Acquired with a Remidio FOP fundus camera, retinal fundus photograph:
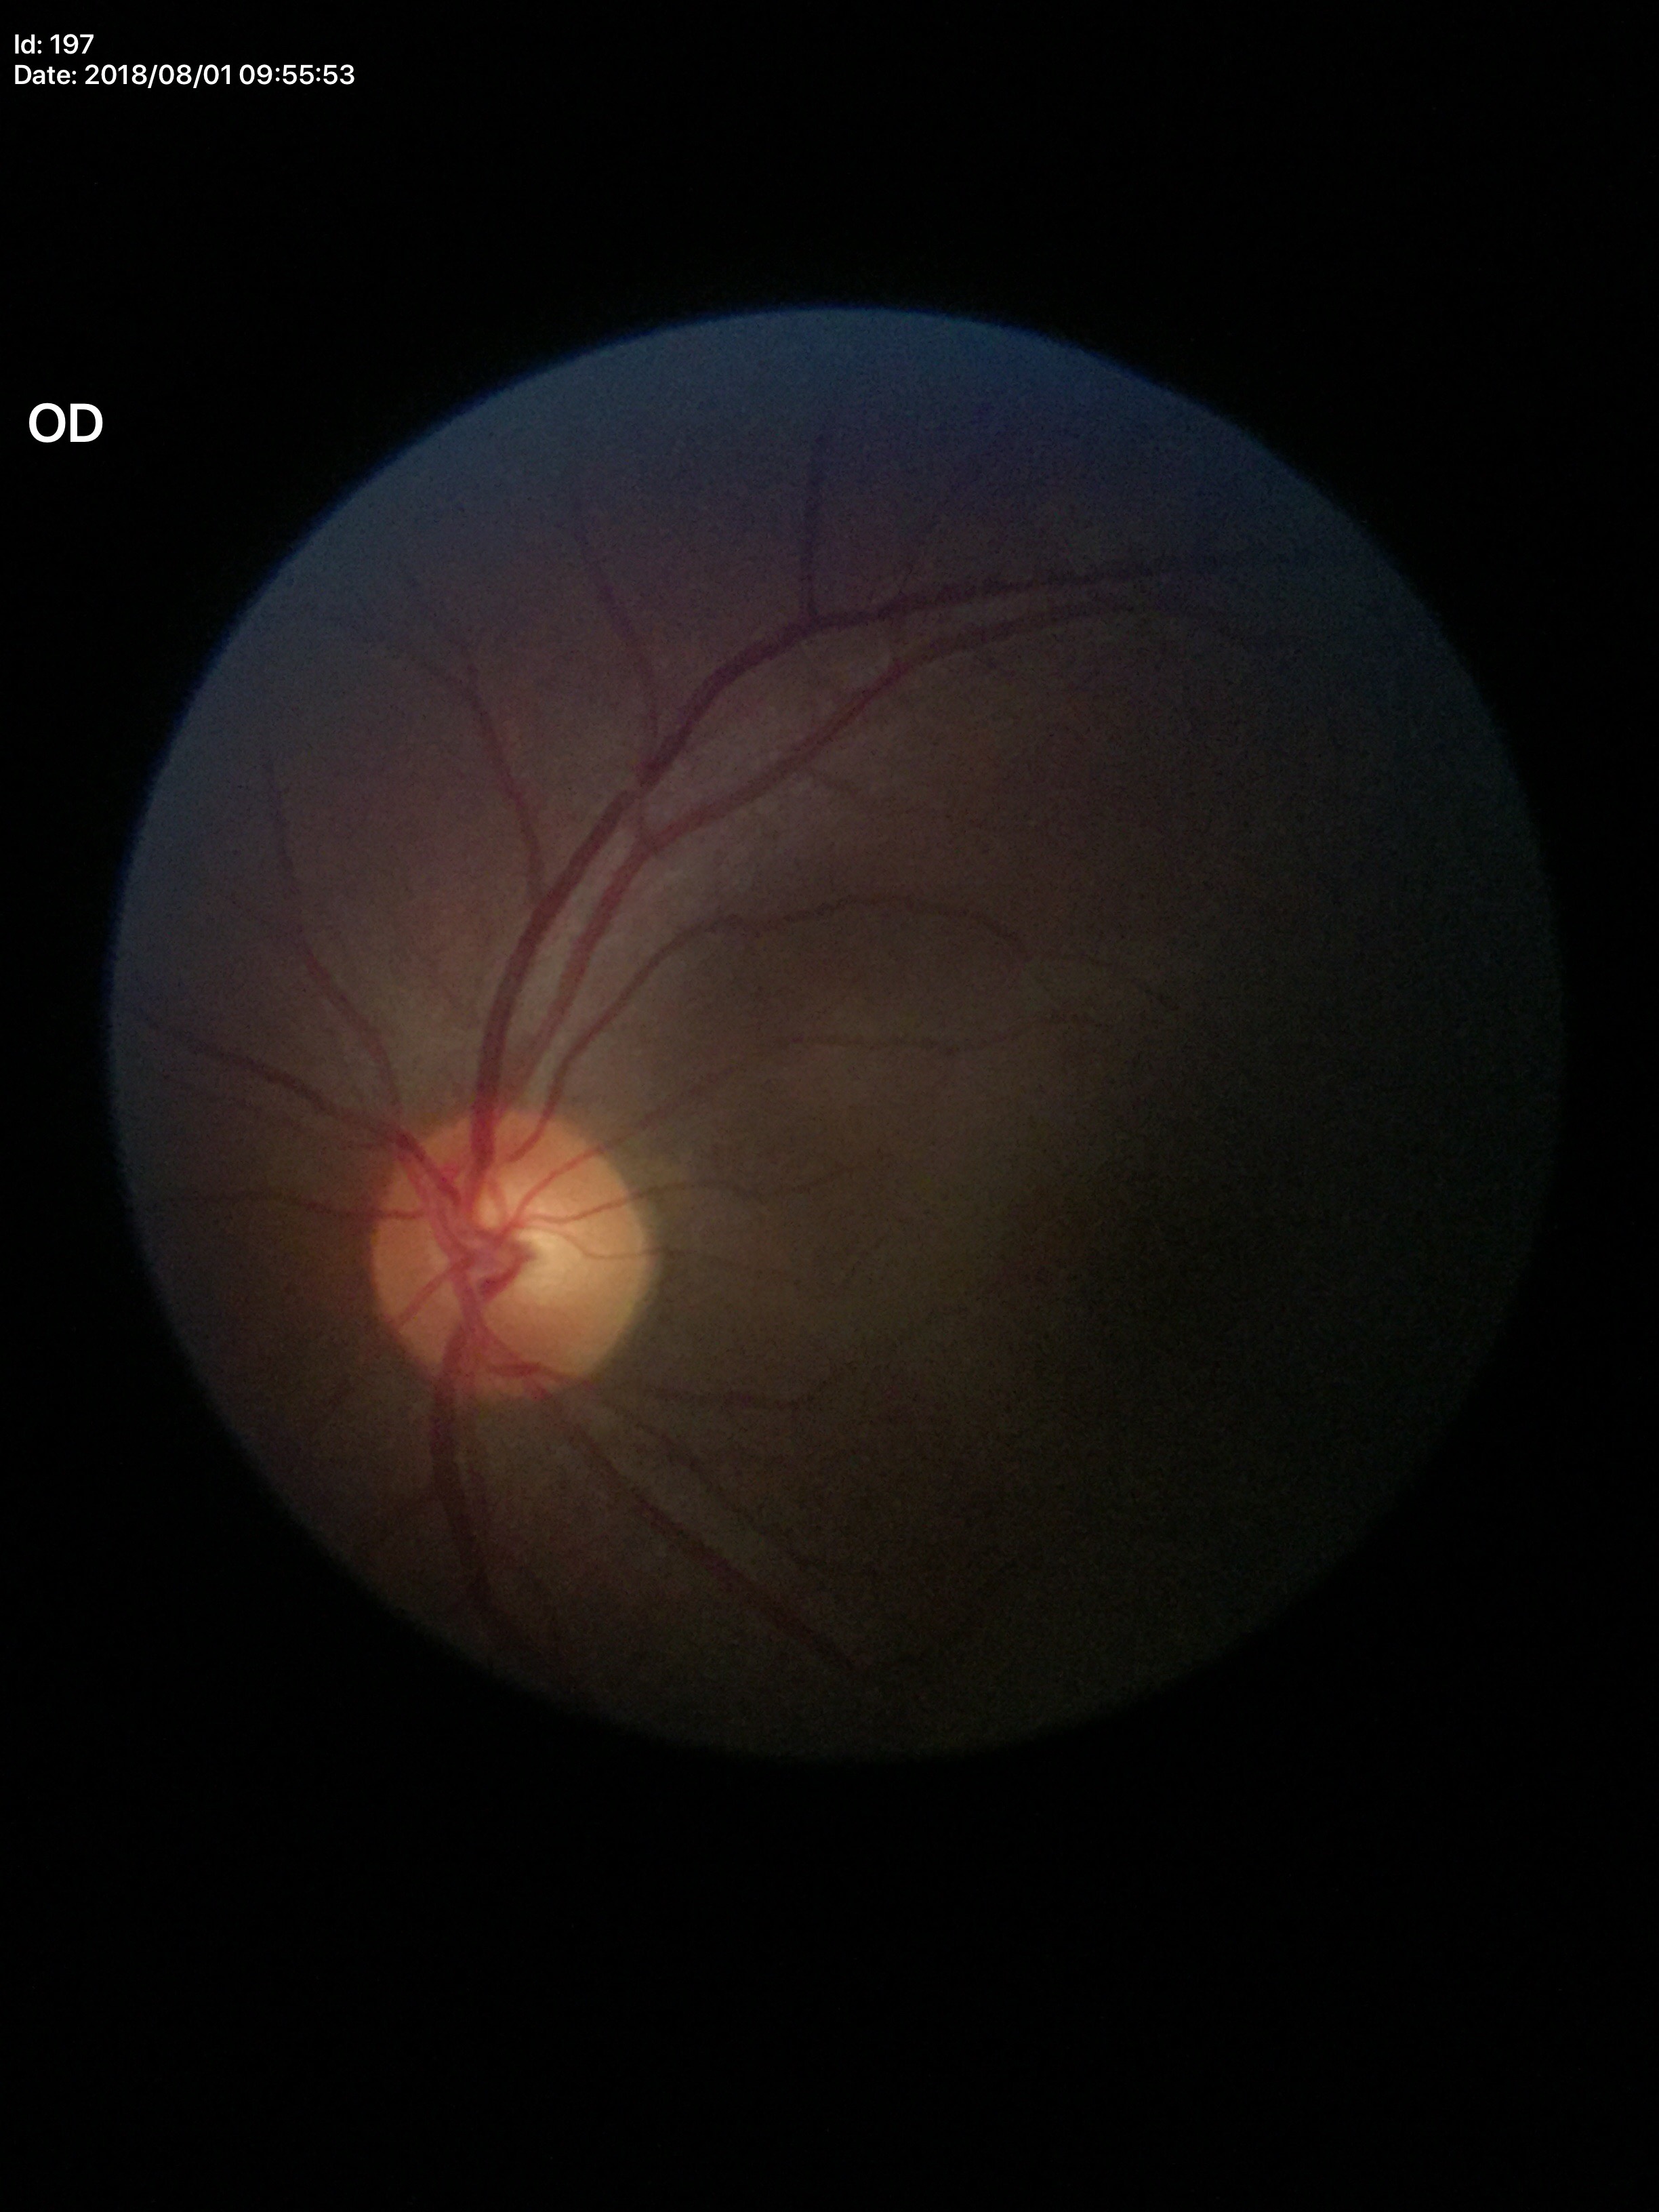

No glaucomatous optic neuropathy (1/5 graders called glaucoma suspect).
Vertical cup-to-disc ratio: 0.53.